Centered on the macula — 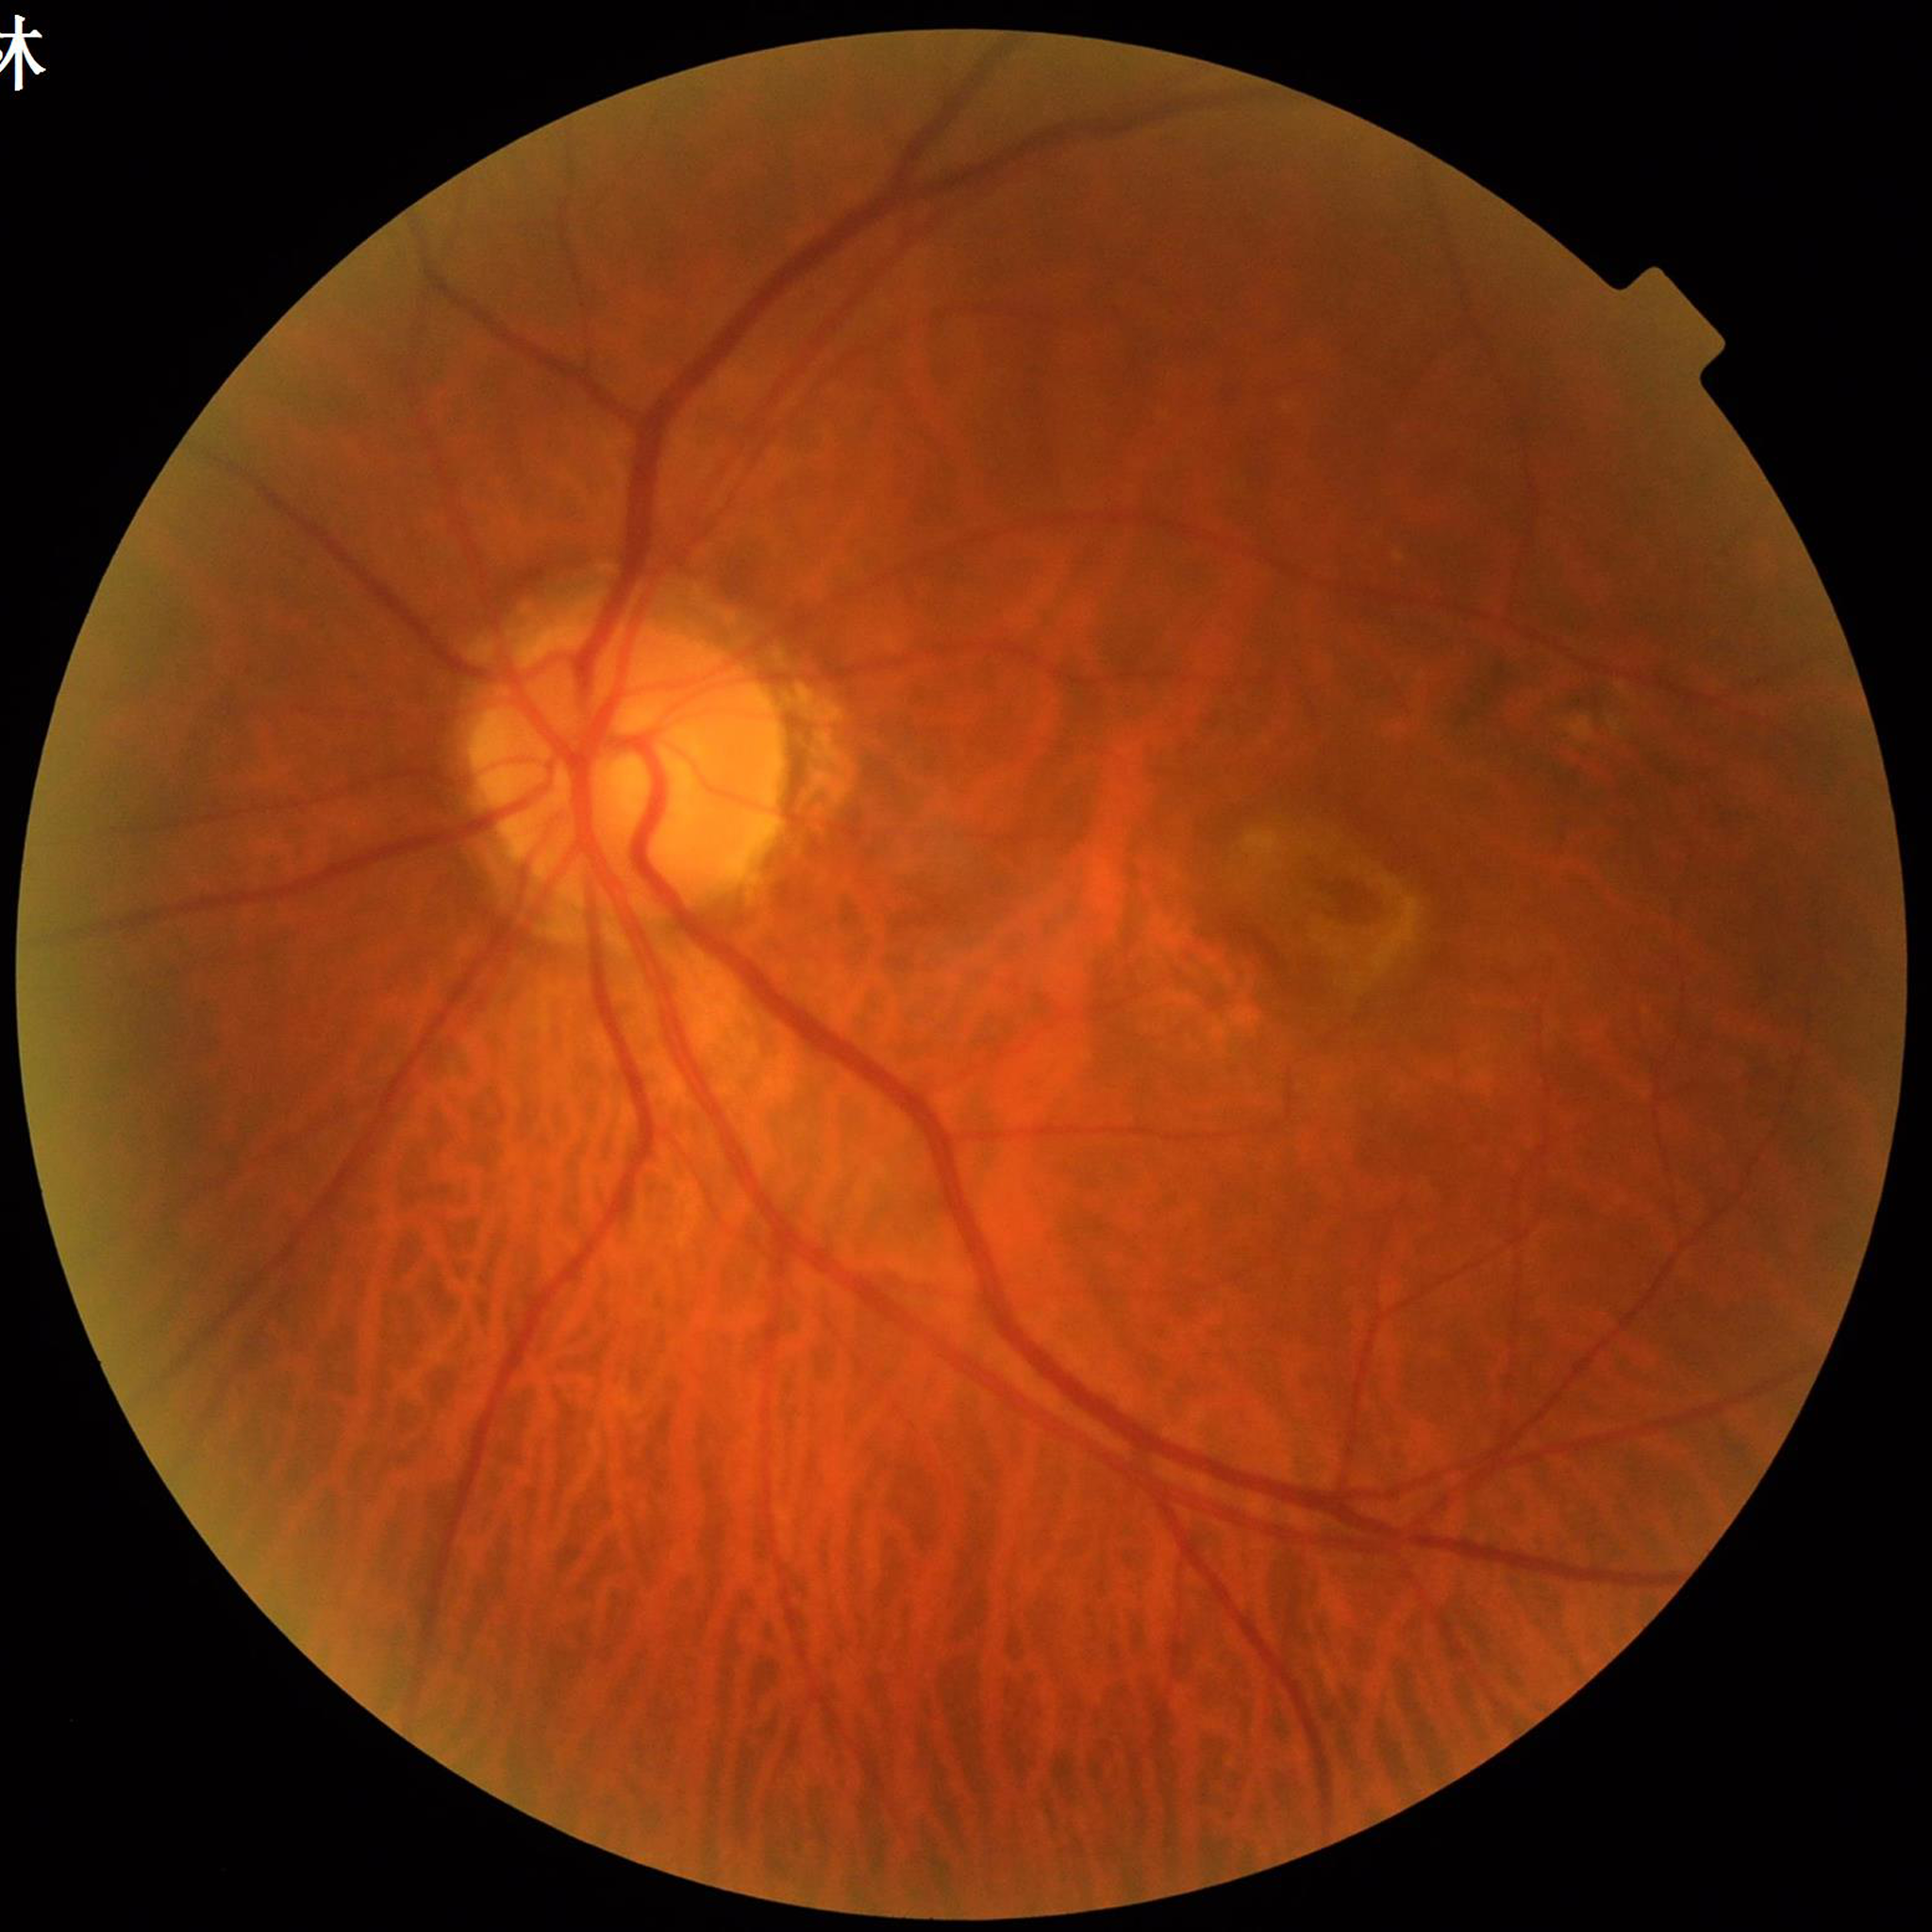
Color fundus photograph from a patient diagnosed with AMD.